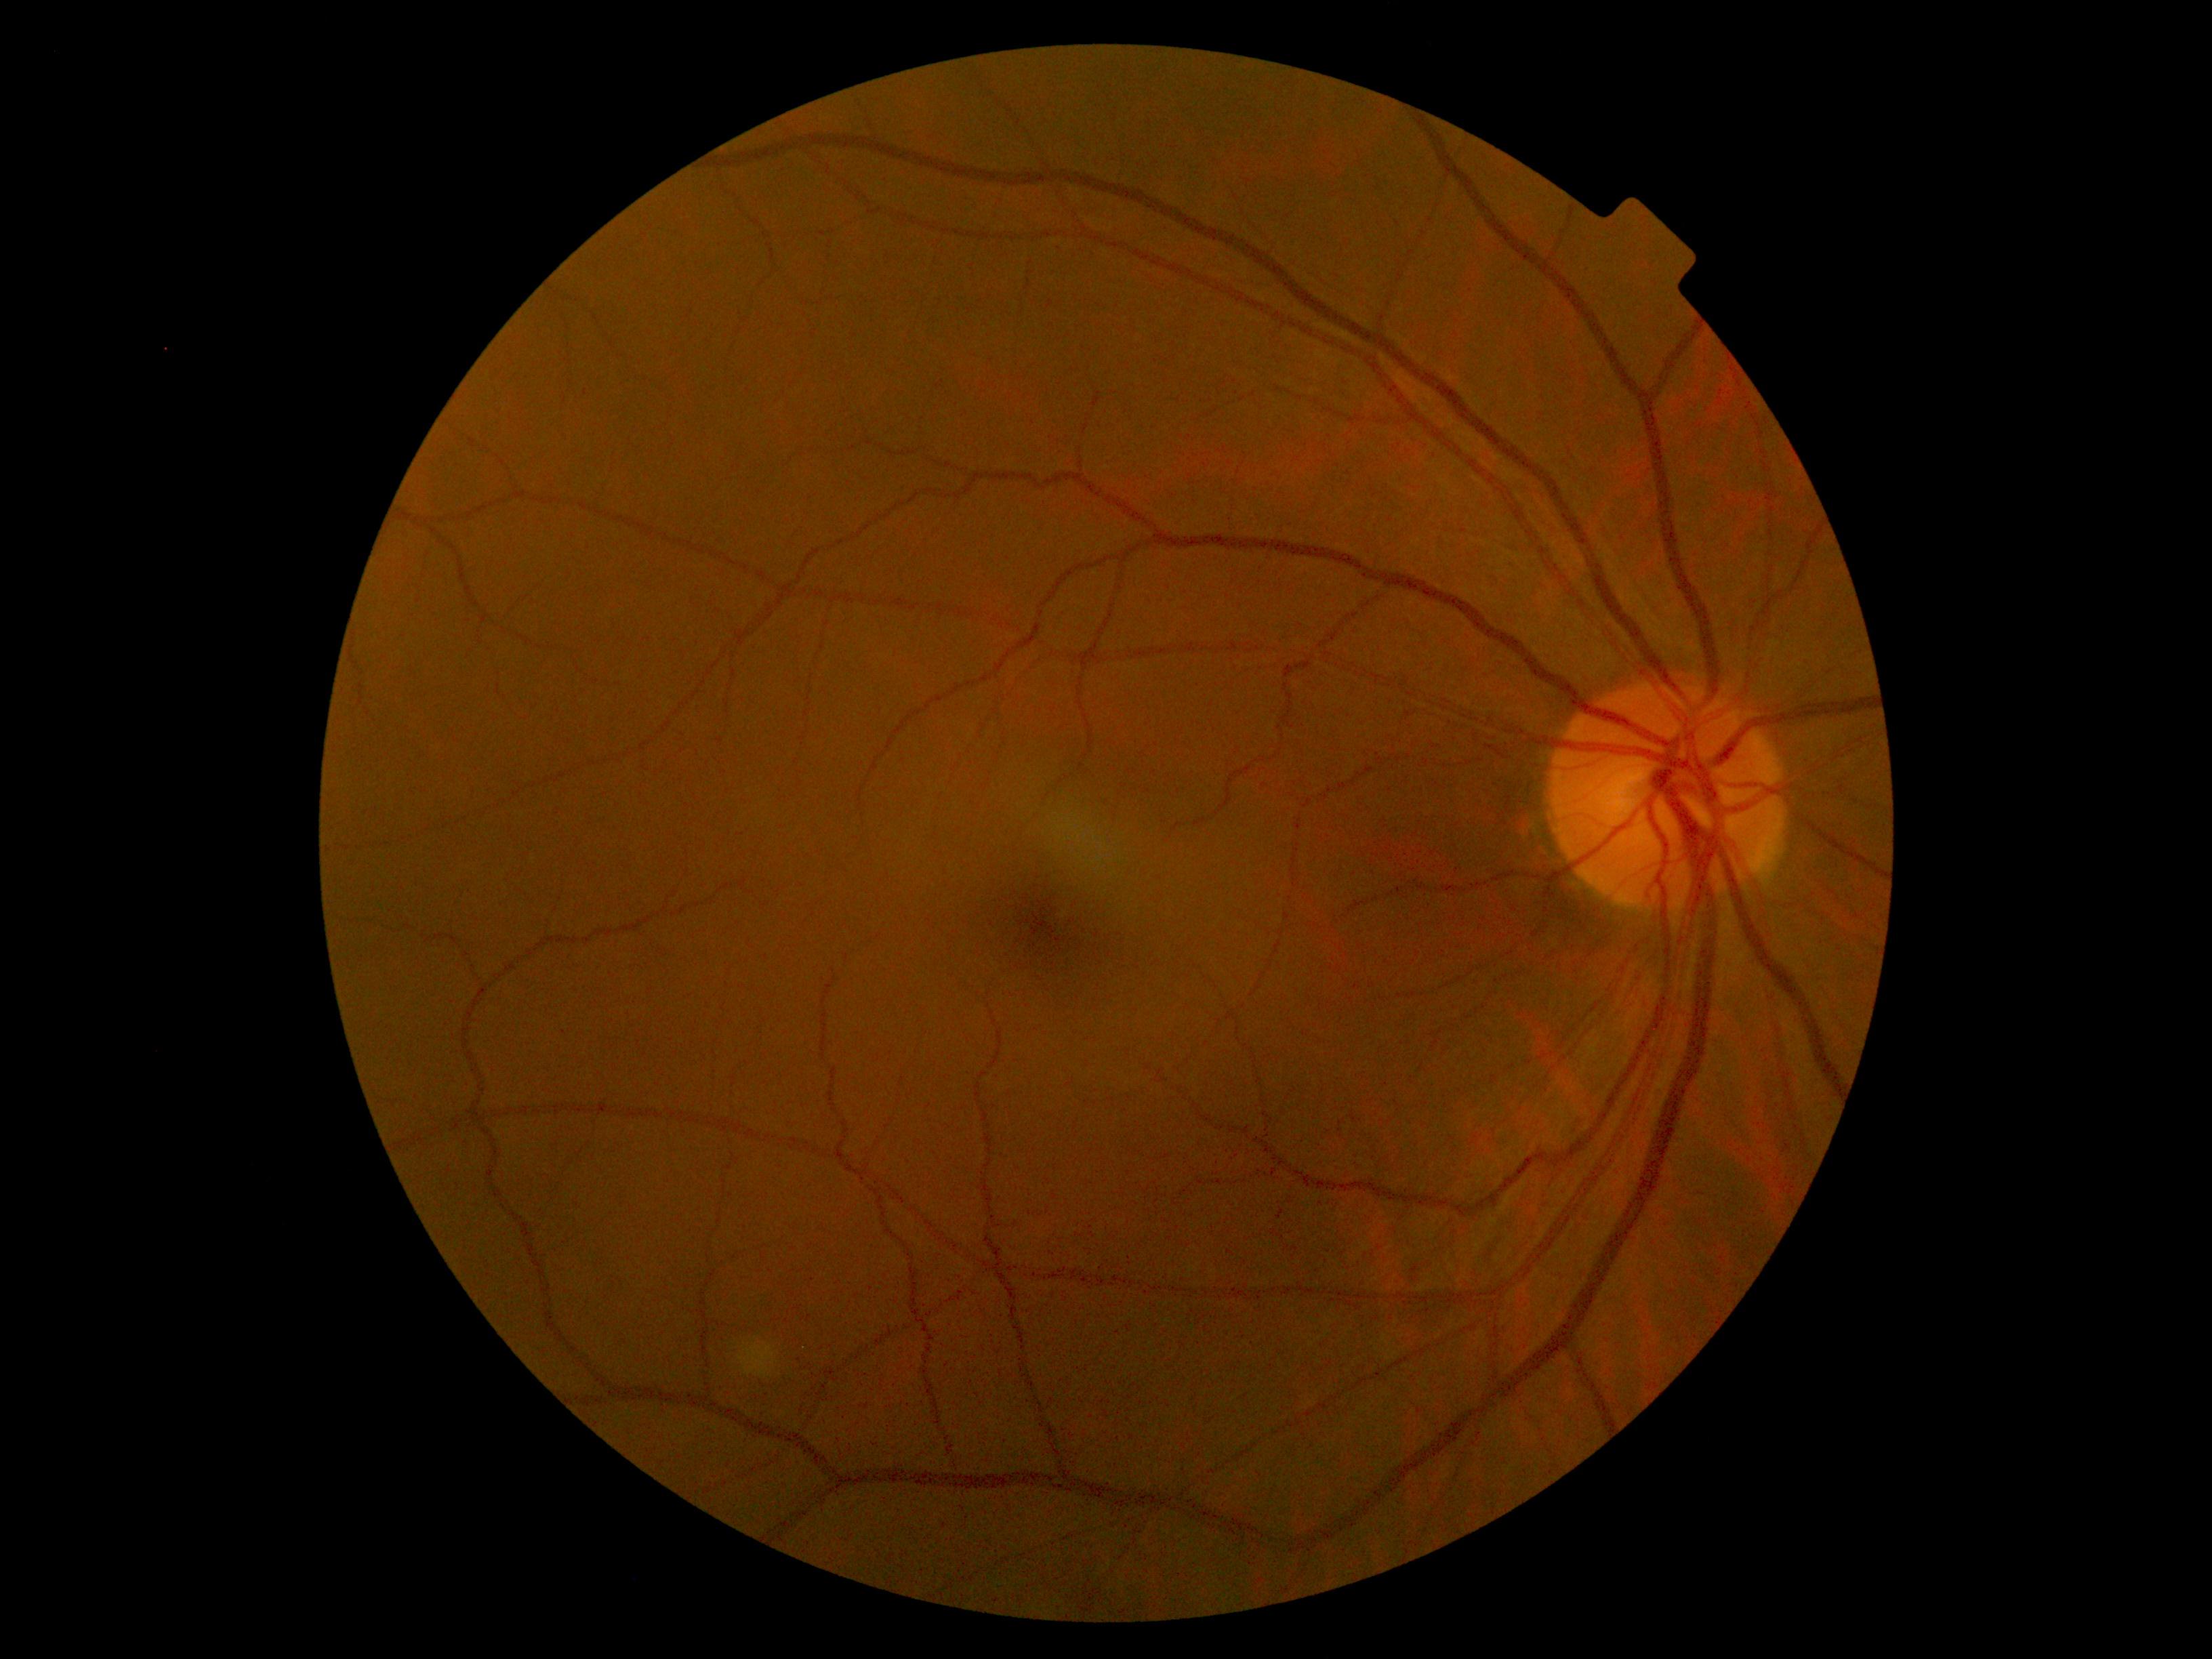 Diabetic retinopathy is 0.